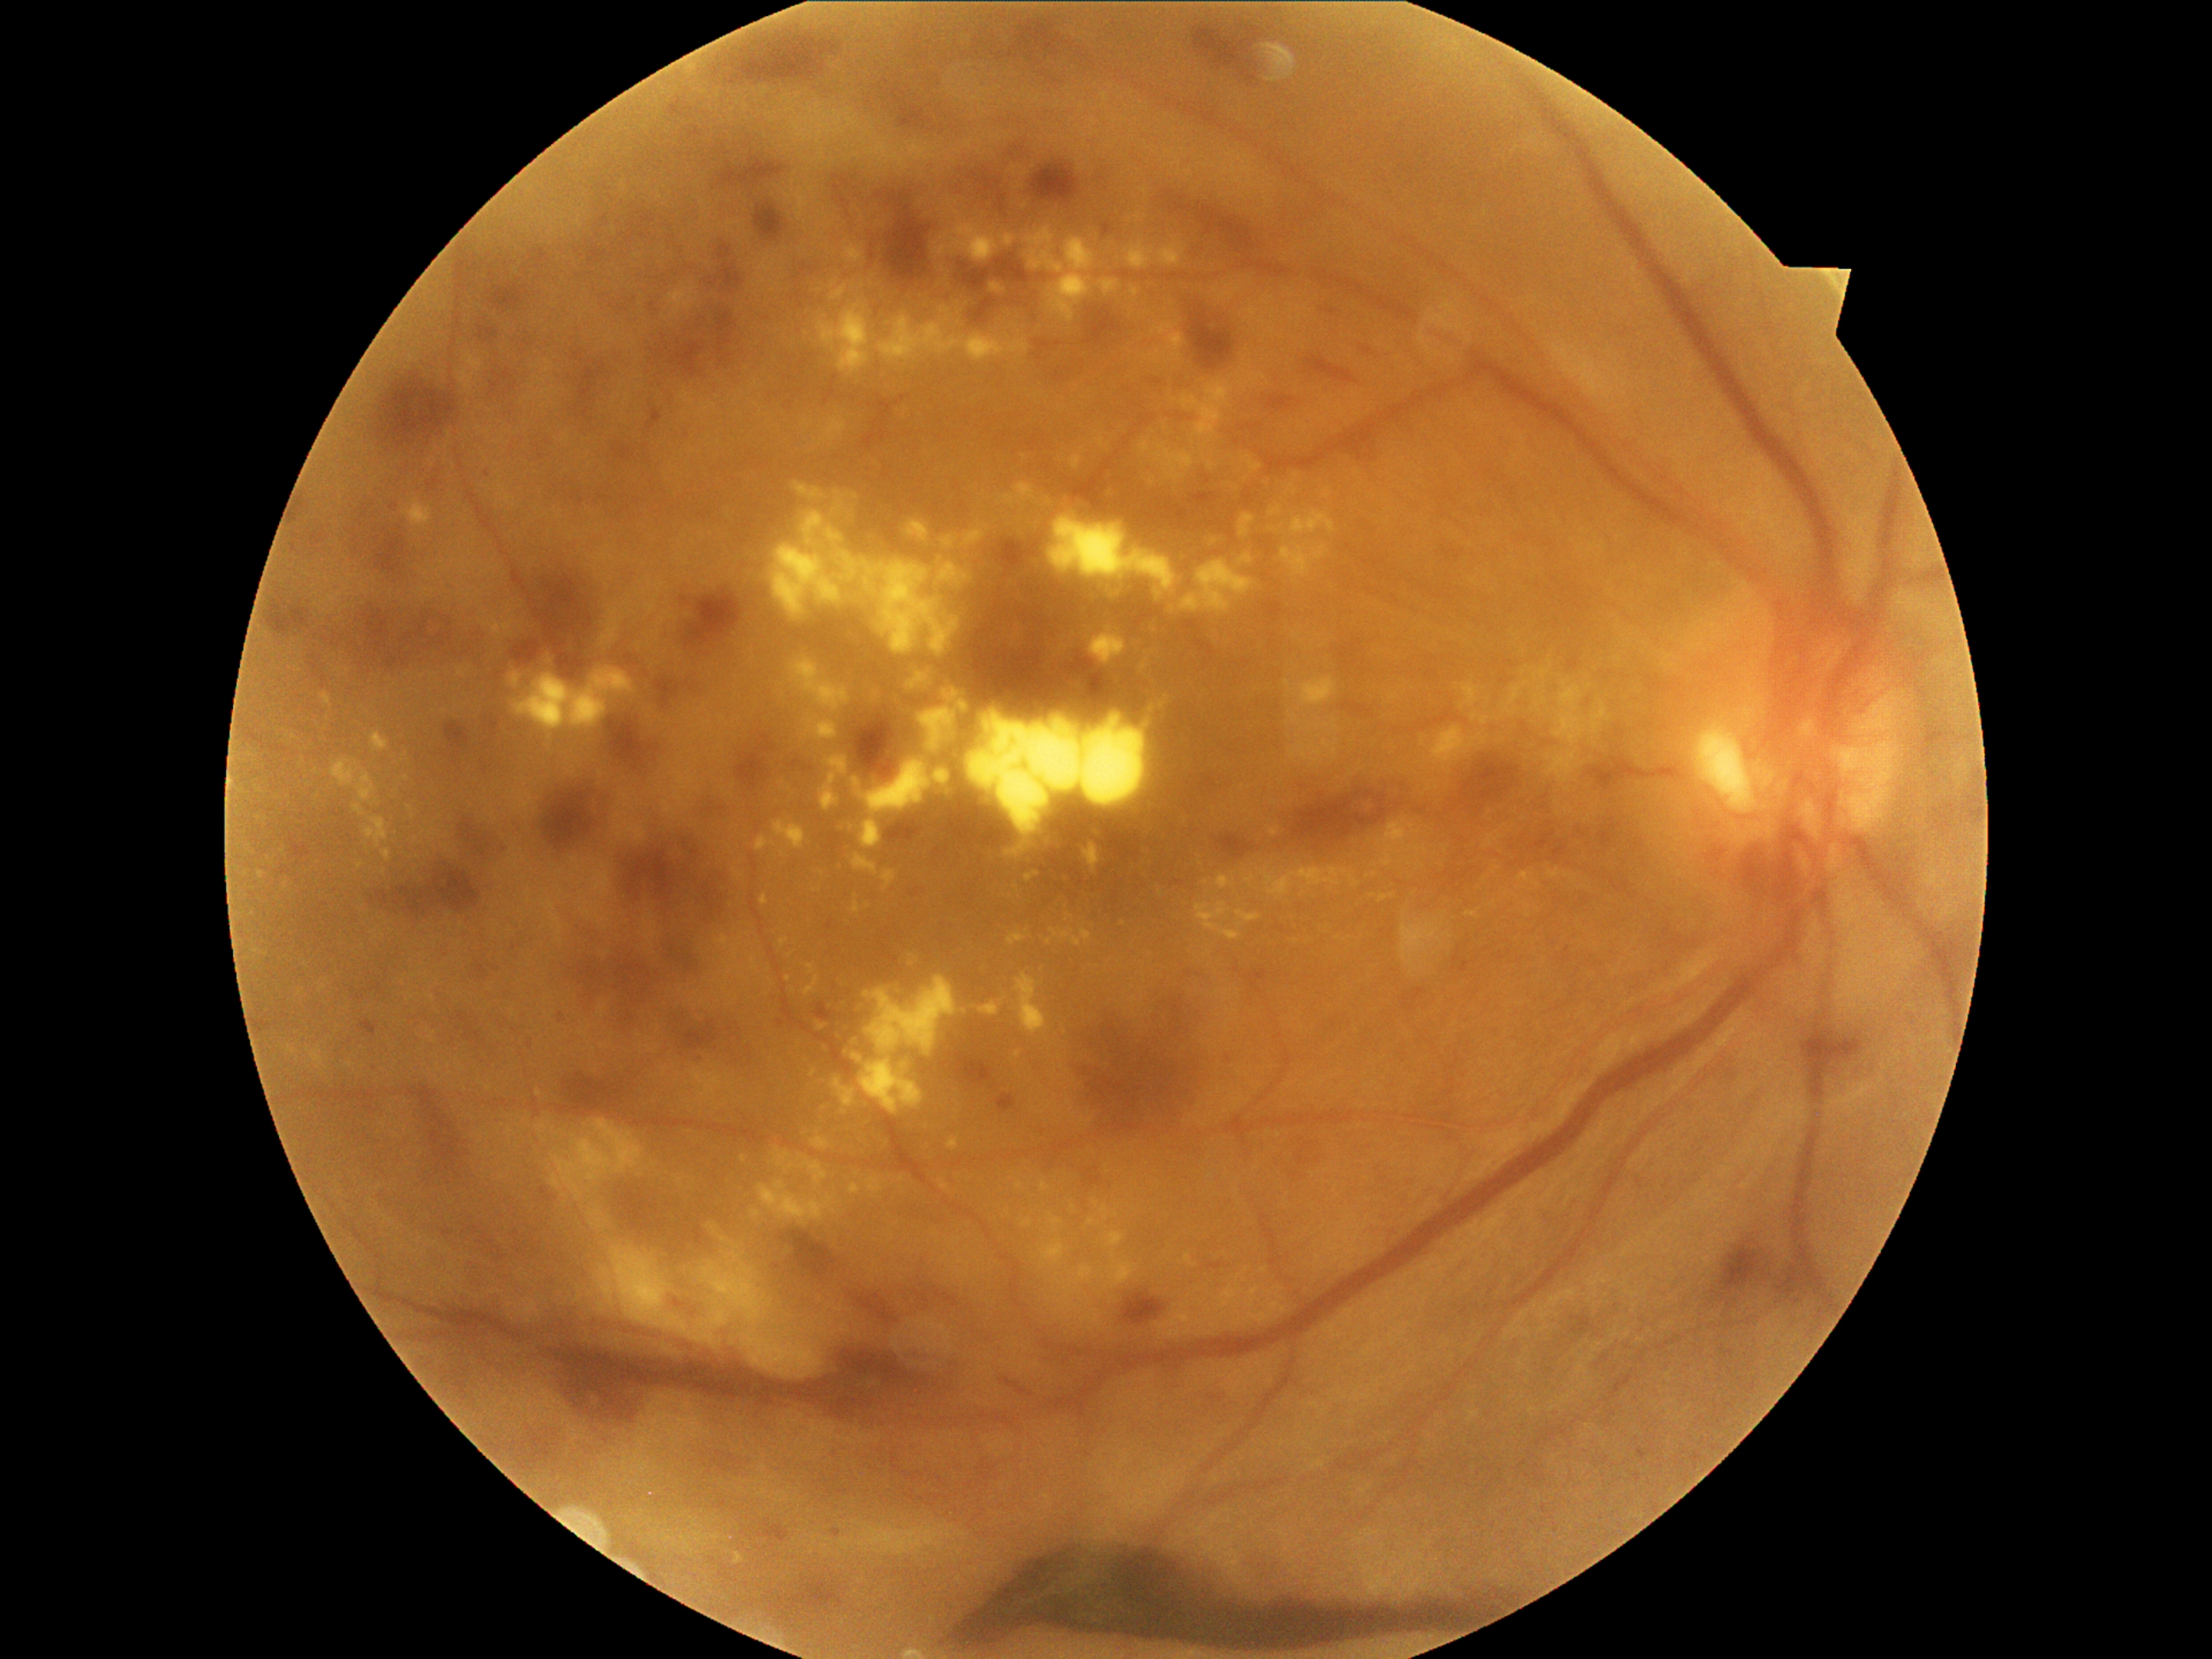

Diabetic retinopathy: proliferative diabetic retinopathy (grade 4)
A subset of detected lesions:
• hard exudates (continued): {"left": 407, "top": 806, "right": 416, "bottom": 820}, {"left": 511, "top": 667, "right": 637, "bottom": 740}, {"left": 1378, "top": 894, "right": 1395, "bottom": 902}, {"left": 1289, "top": 740, "right": 1339, "bottom": 765}, {"left": 1505, "top": 709, "right": 1515, "bottom": 716}, {"left": 1184, "top": 1254, "right": 1197, "bottom": 1269}, {"left": 1245, "top": 1301, "right": 1281, "bottom": 1324}, {"left": 332, "top": 760, "right": 381, "bottom": 806}, {"left": 1245, "top": 1286, "right": 1260, "bottom": 1308}, {"left": 1460, "top": 684, "right": 1481, "bottom": 709}, {"left": 979, "top": 1003, "right": 999, "bottom": 1016}, {"left": 760, "top": 895, "right": 769, "bottom": 905}
• Small hard exudates near pt(1187, 1332), pt(1499, 836), pt(720, 983), pt(1373, 866), pt(1091, 1223), pt(1525, 684), pt(856, 896), pt(965, 1011)